Modified Davis classification — 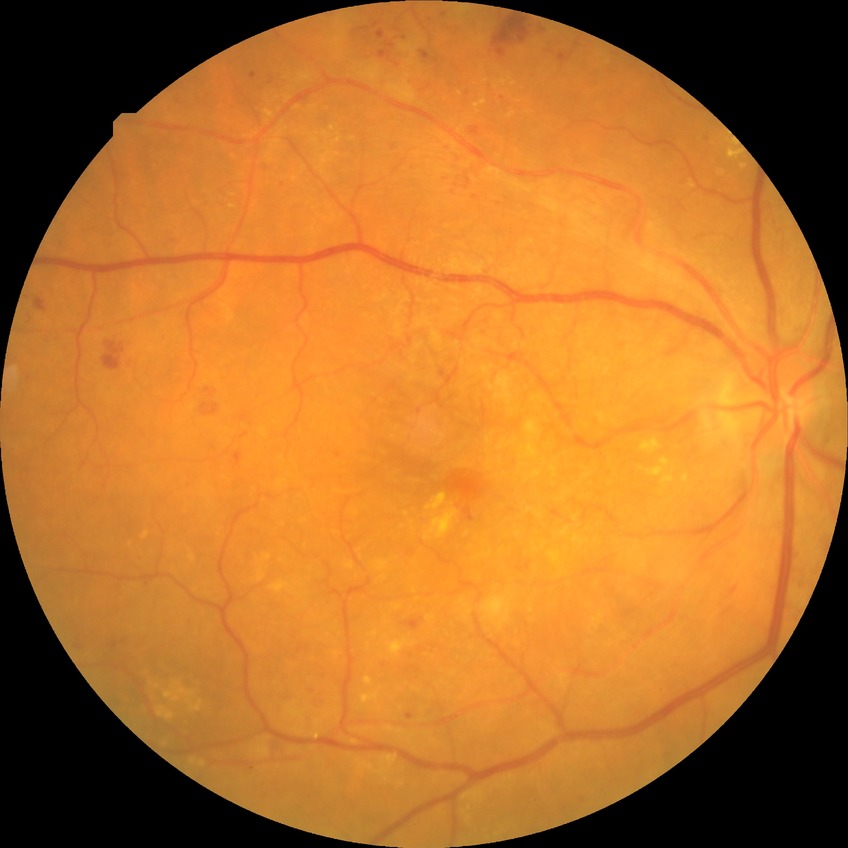
diabetic retinopathy (DR)=PPDR (pre-proliferative diabetic retinopathy).